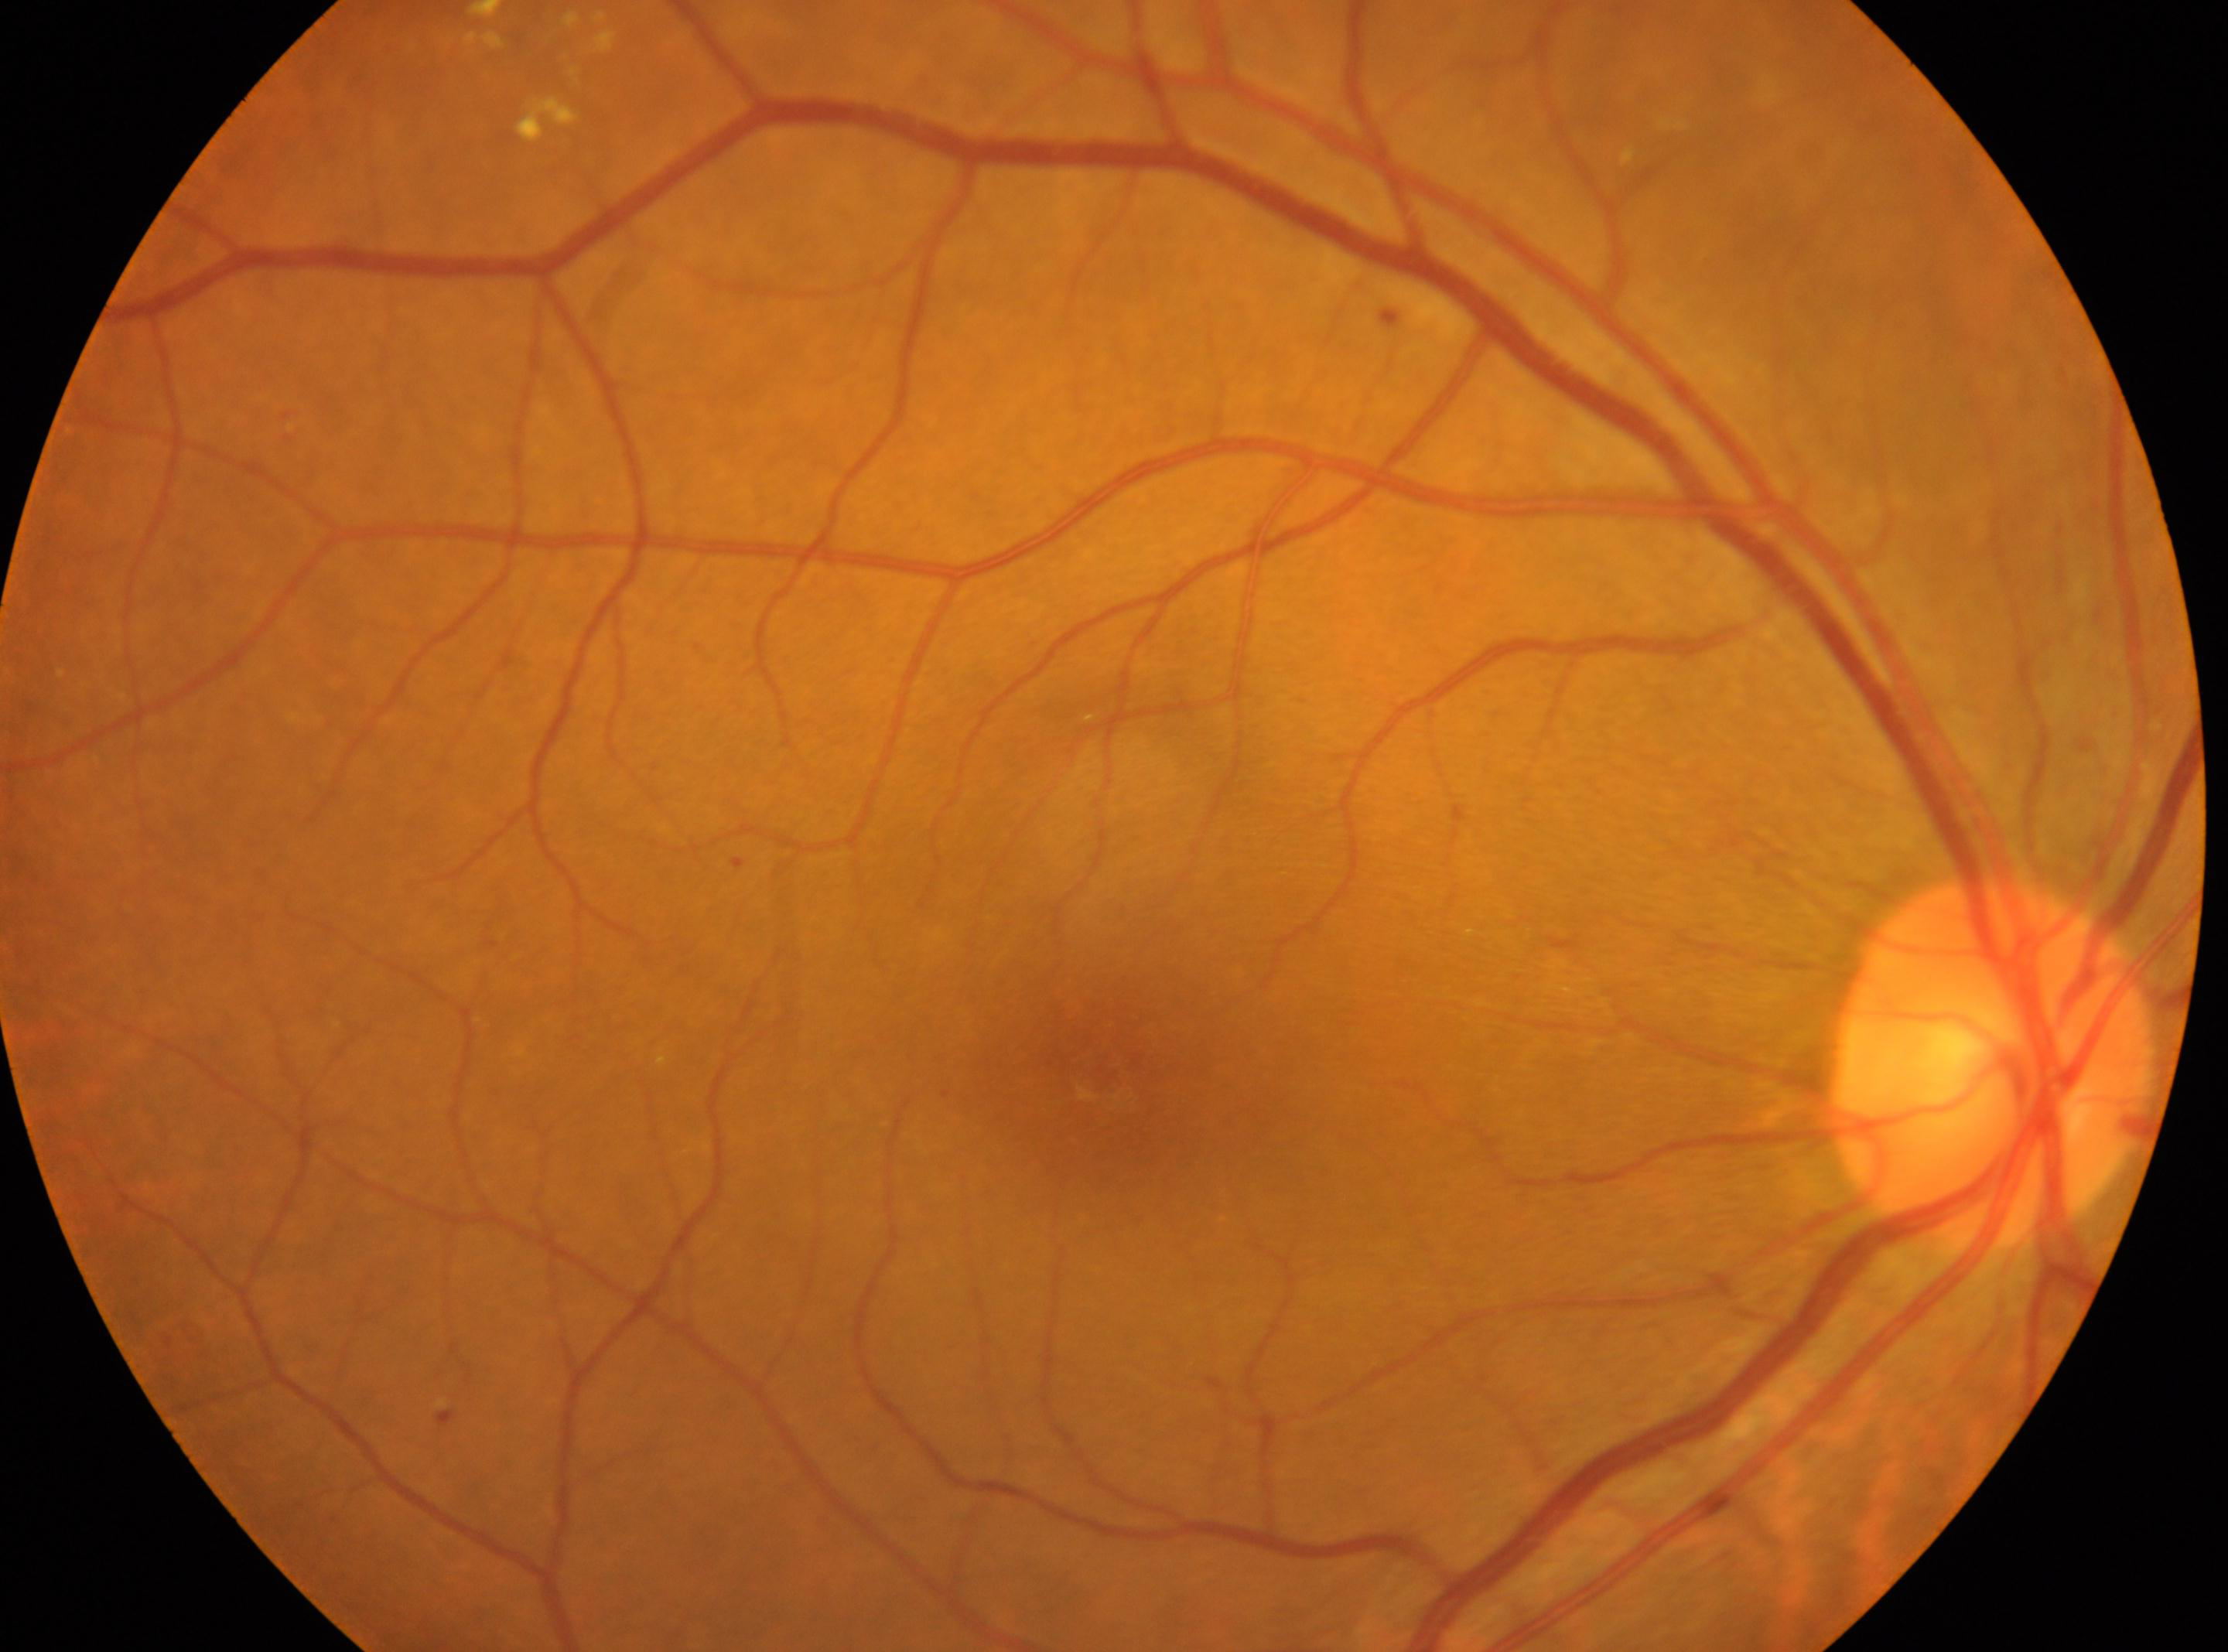
Disc center: [1988, 1061]. The macula center is at [1094, 1063]. The image shows the right eye. Diabetic retinopathy is moderate non-proliferative diabetic retinopathy (grade 2).